Image size 1960x1897 — 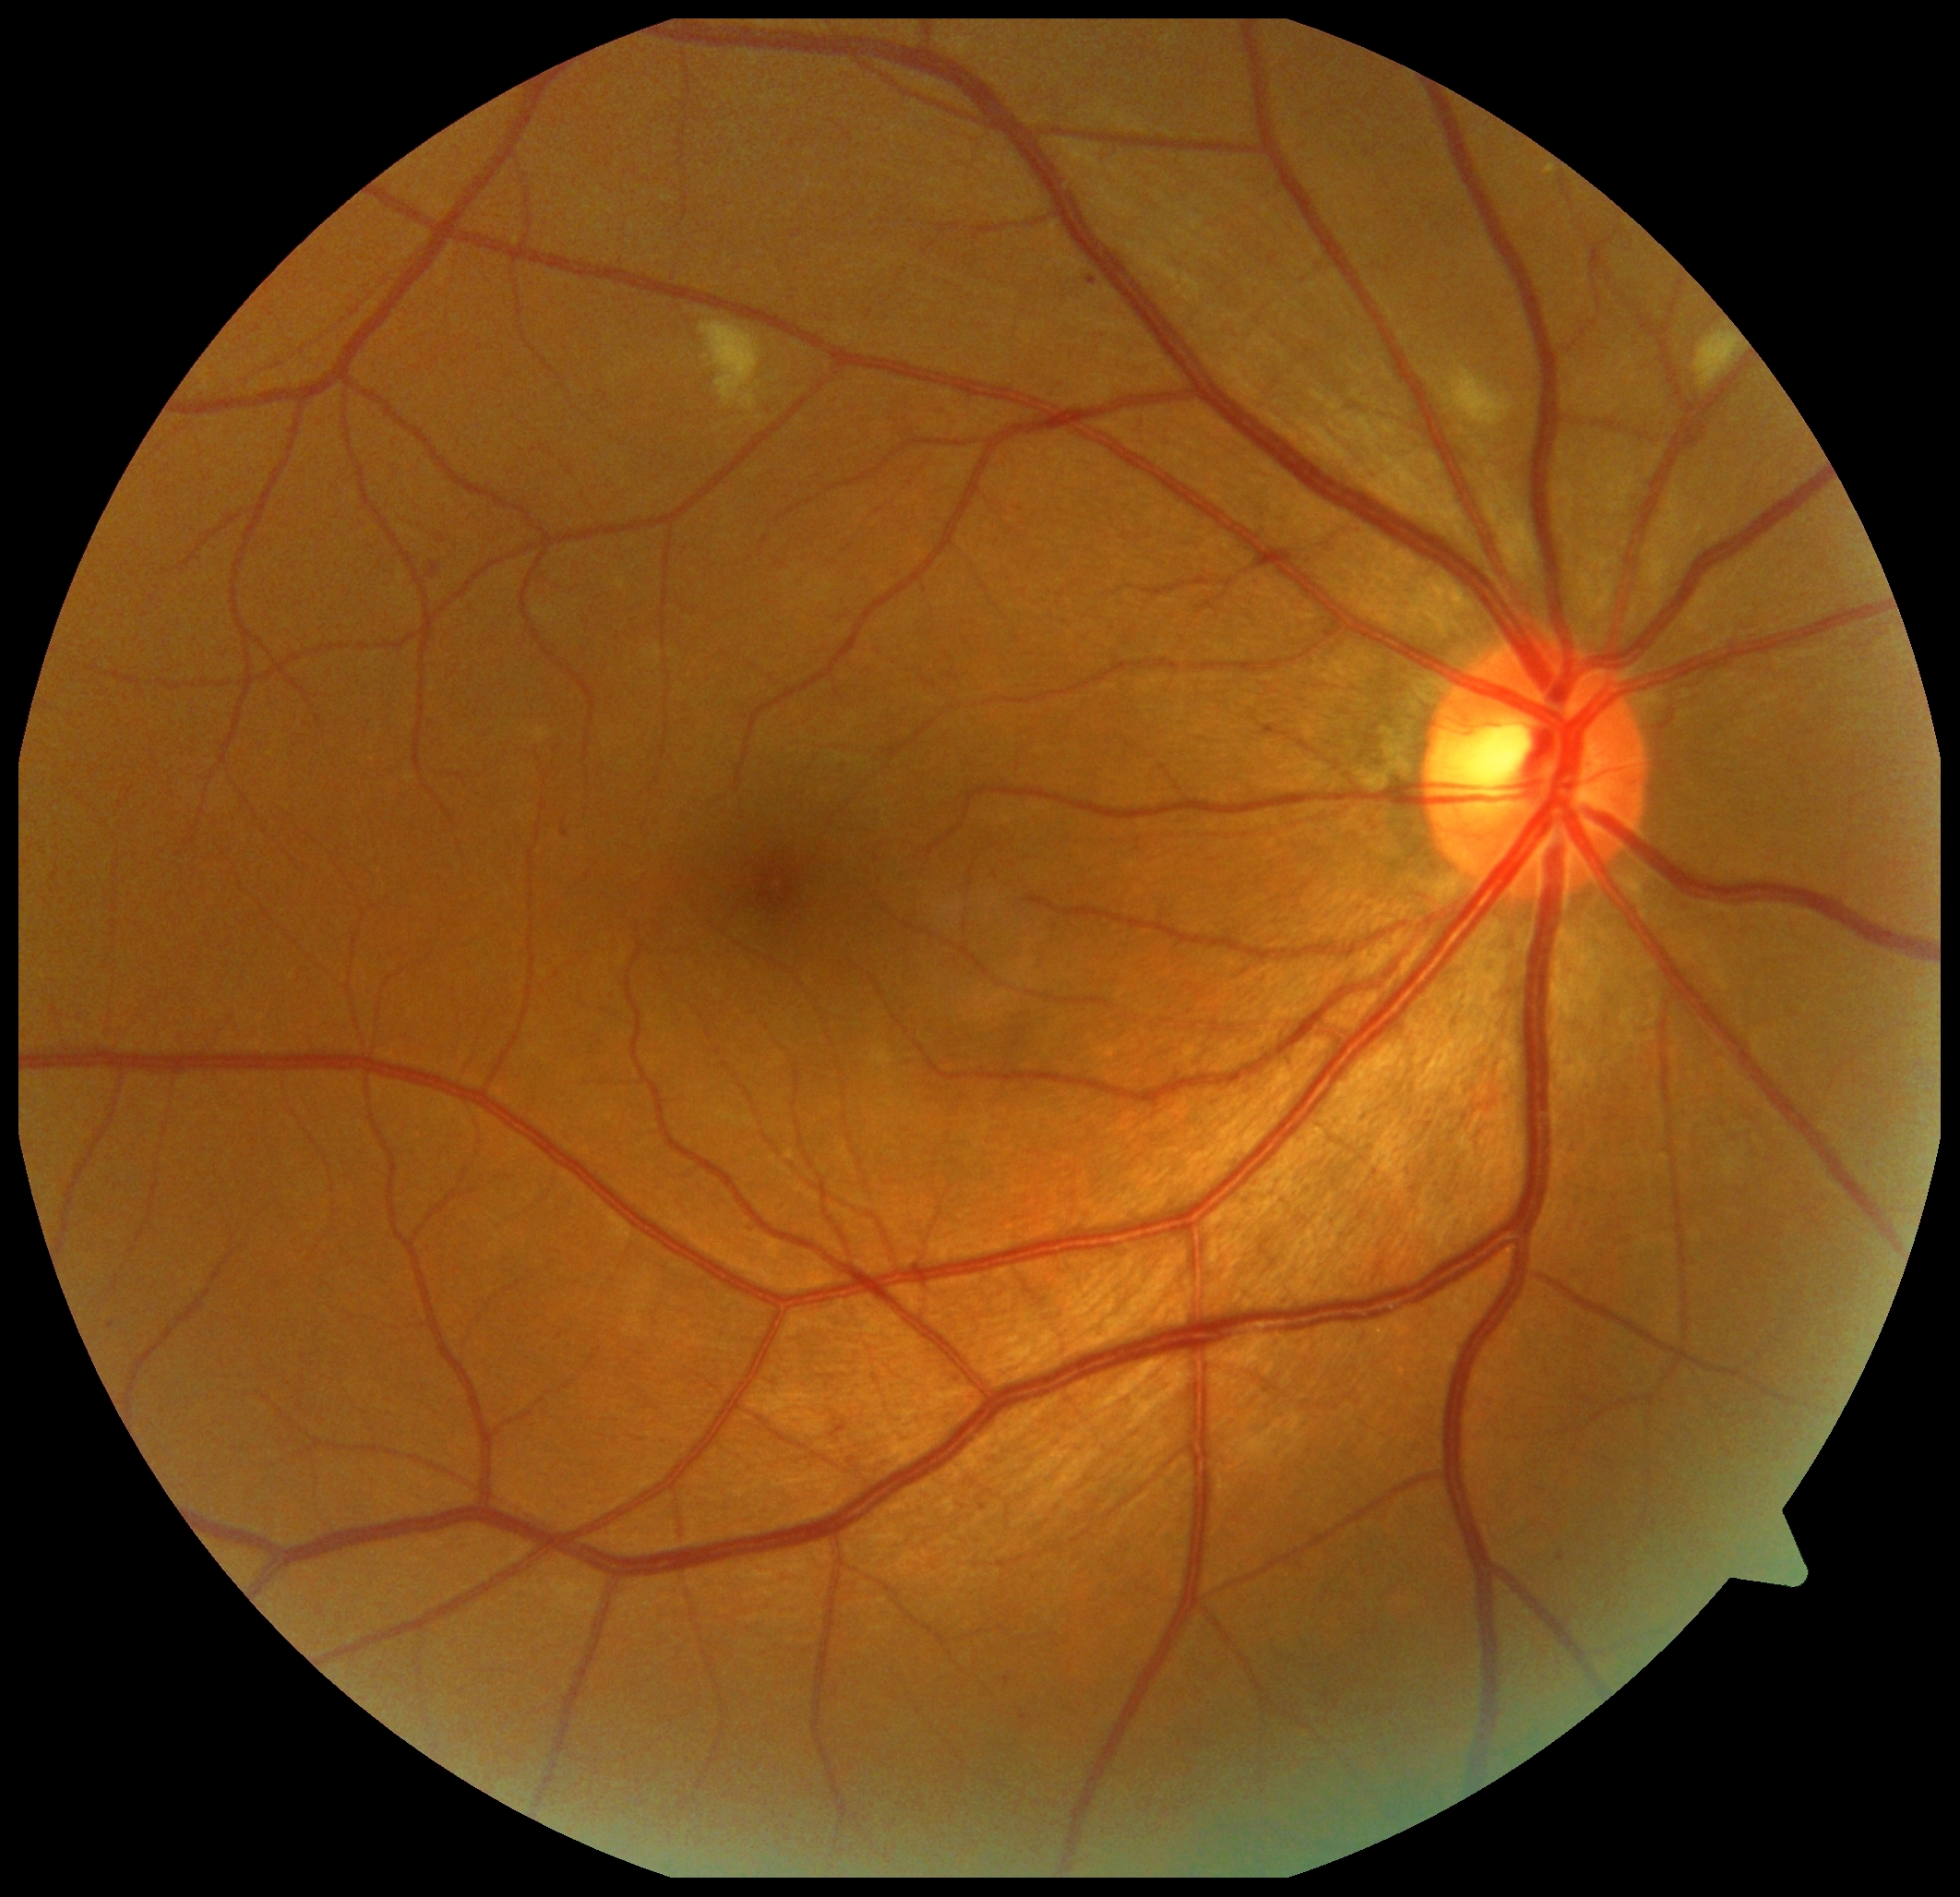

Findings:
- DR grade: moderate non-proliferative diabetic retinopathy (2)
- DR class: non-proliferative diabetic retinopathy